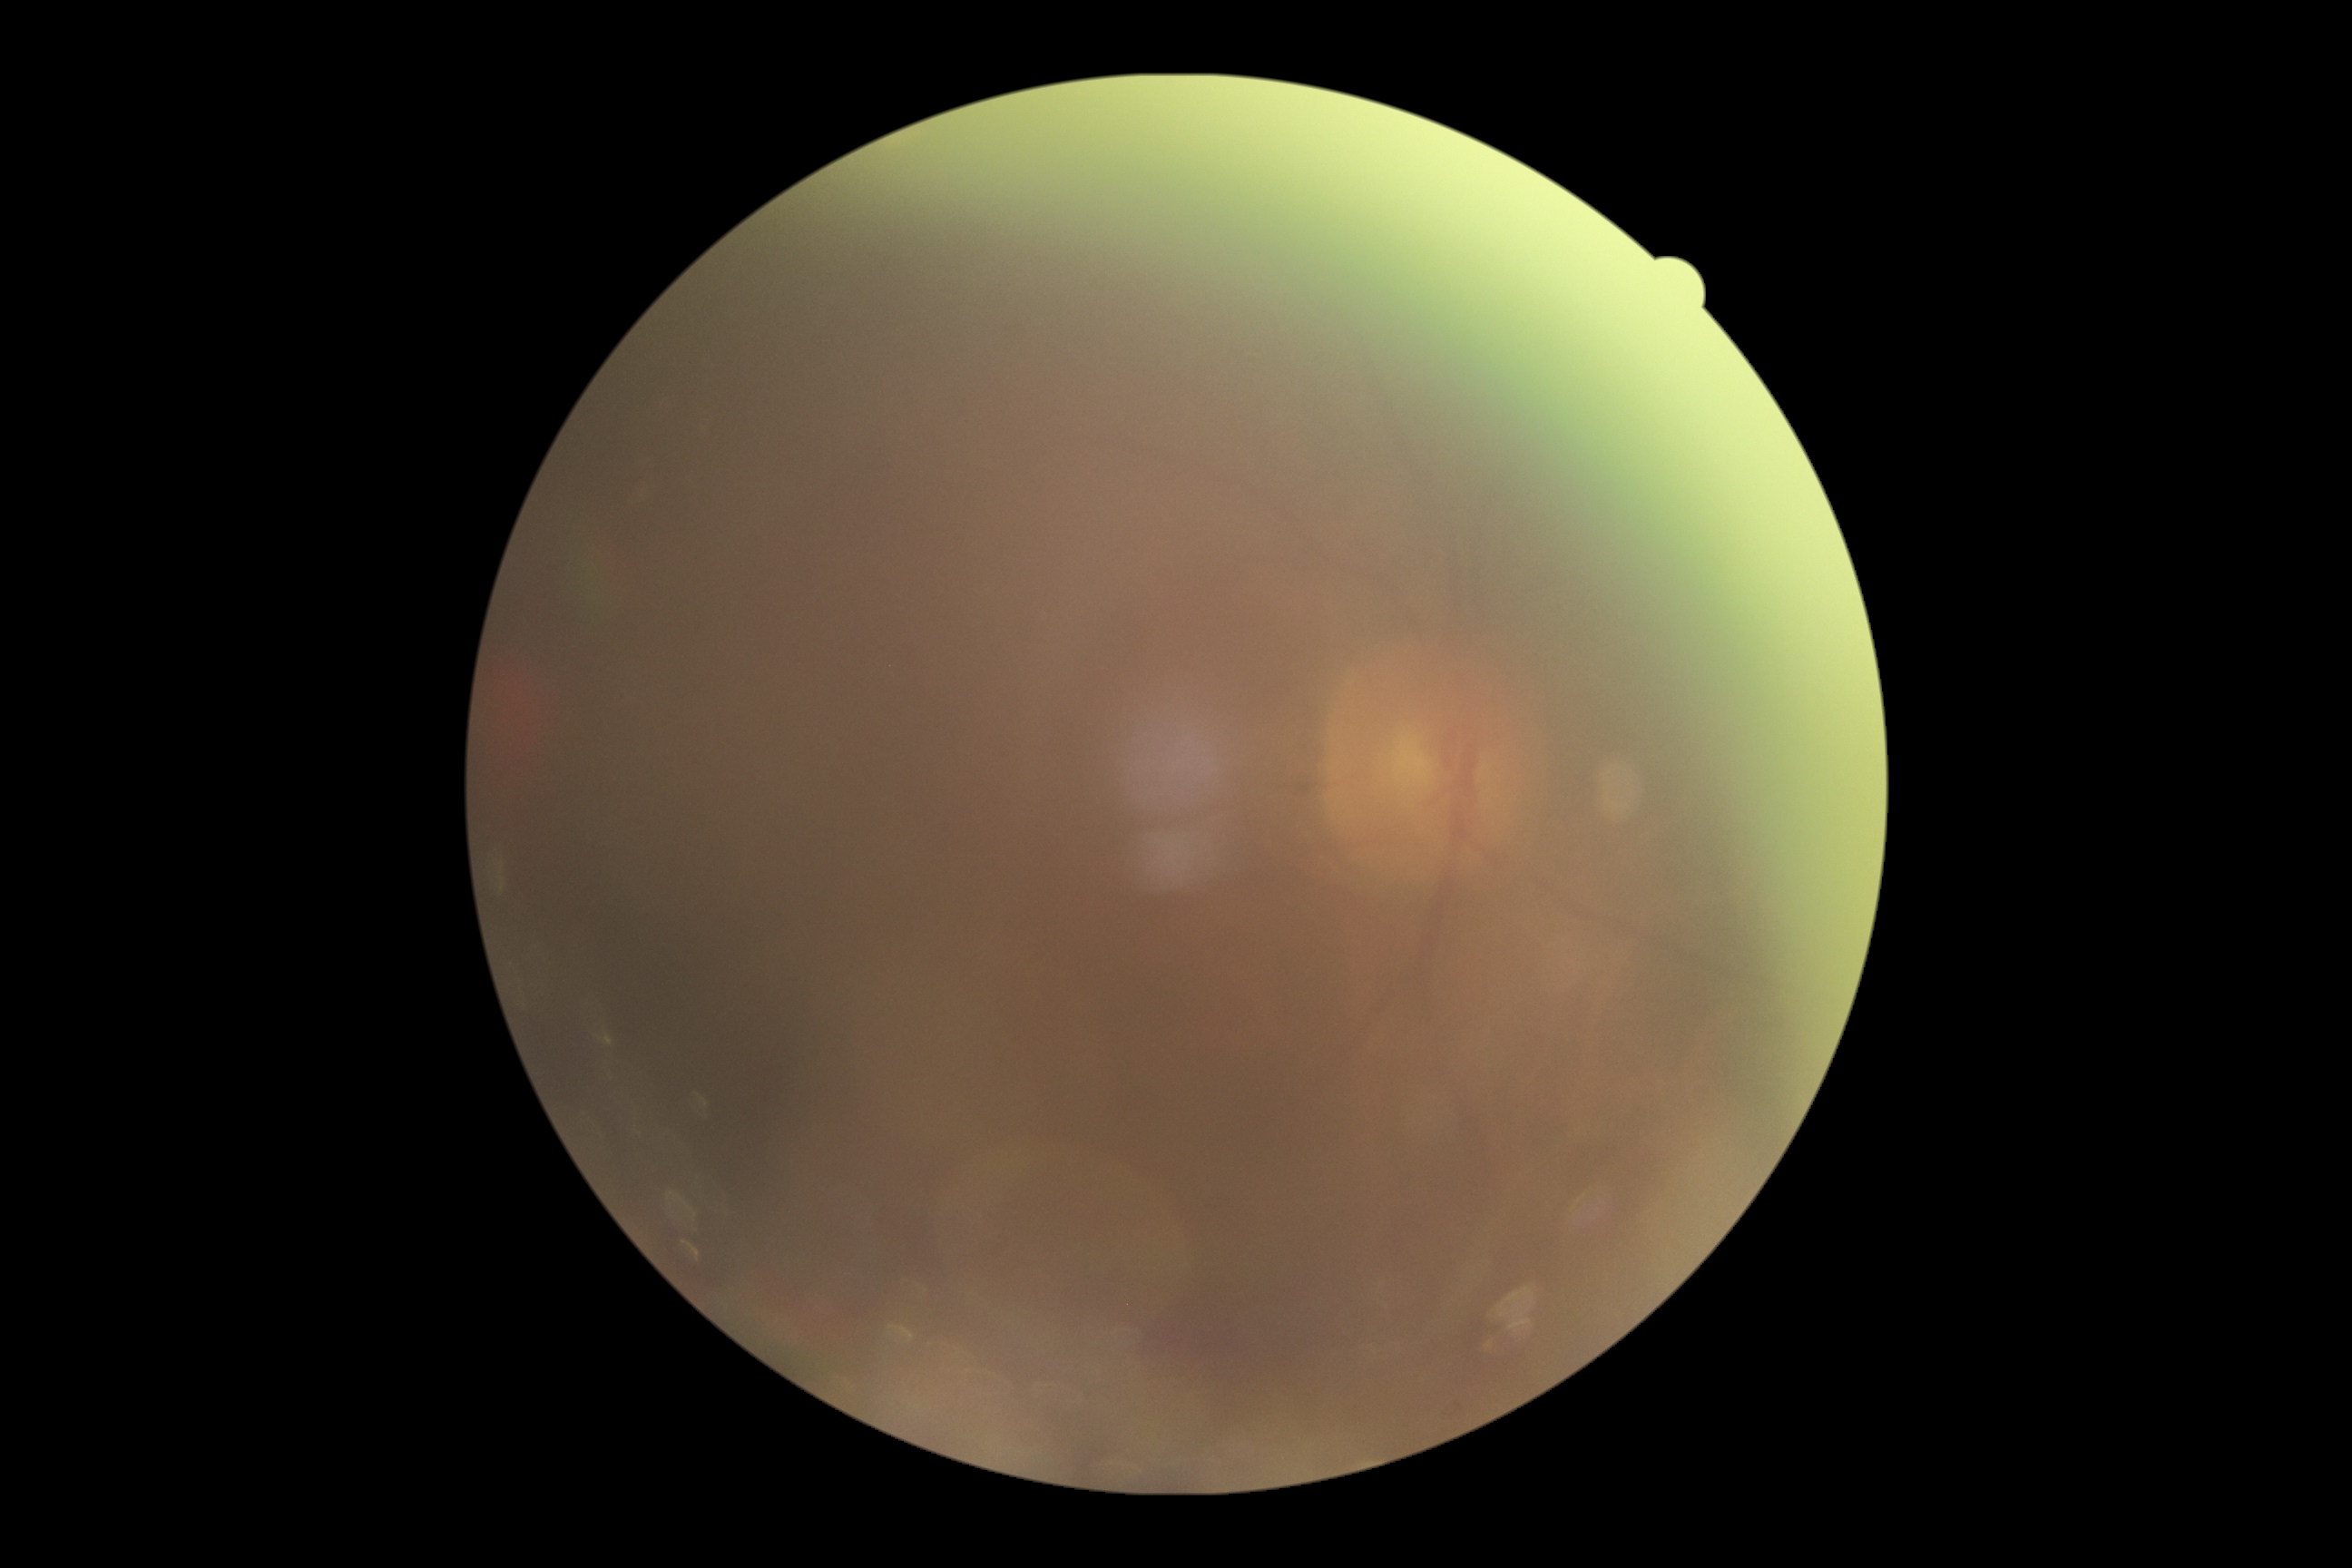 Quality too poor to assess for DR. Diabetic retinopathy (DR) is ungradable.